Color fundus photograph · graded on the modified Davis scale — 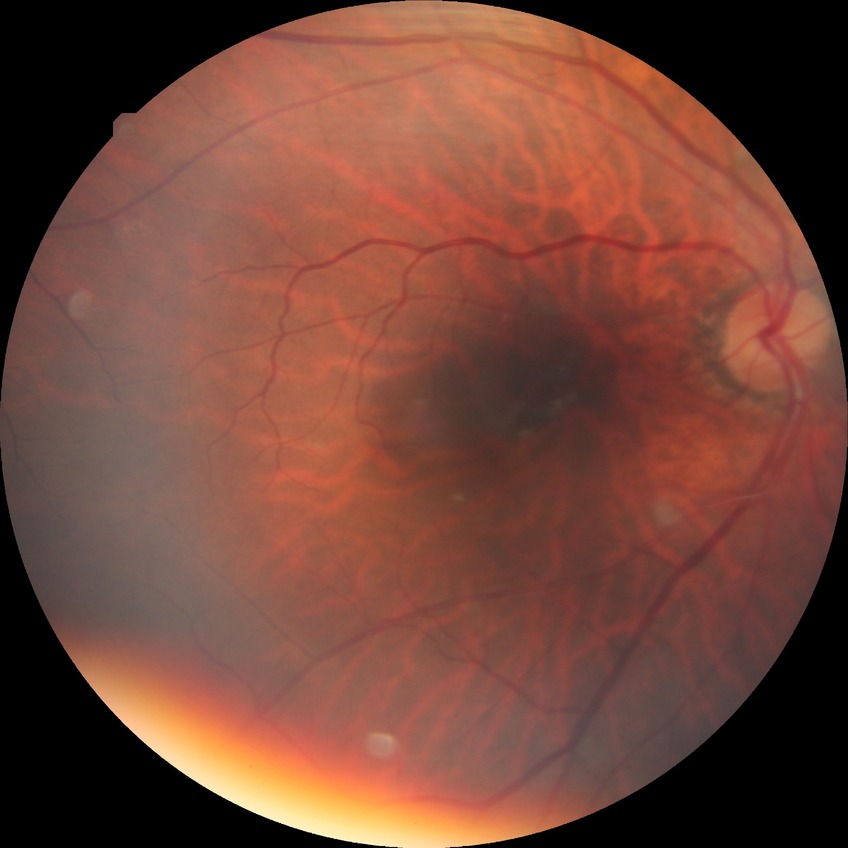 {"davis_grade": "NDR"}